Centered on the macula; camera: Topcon TRC-NW8; 50° FOV
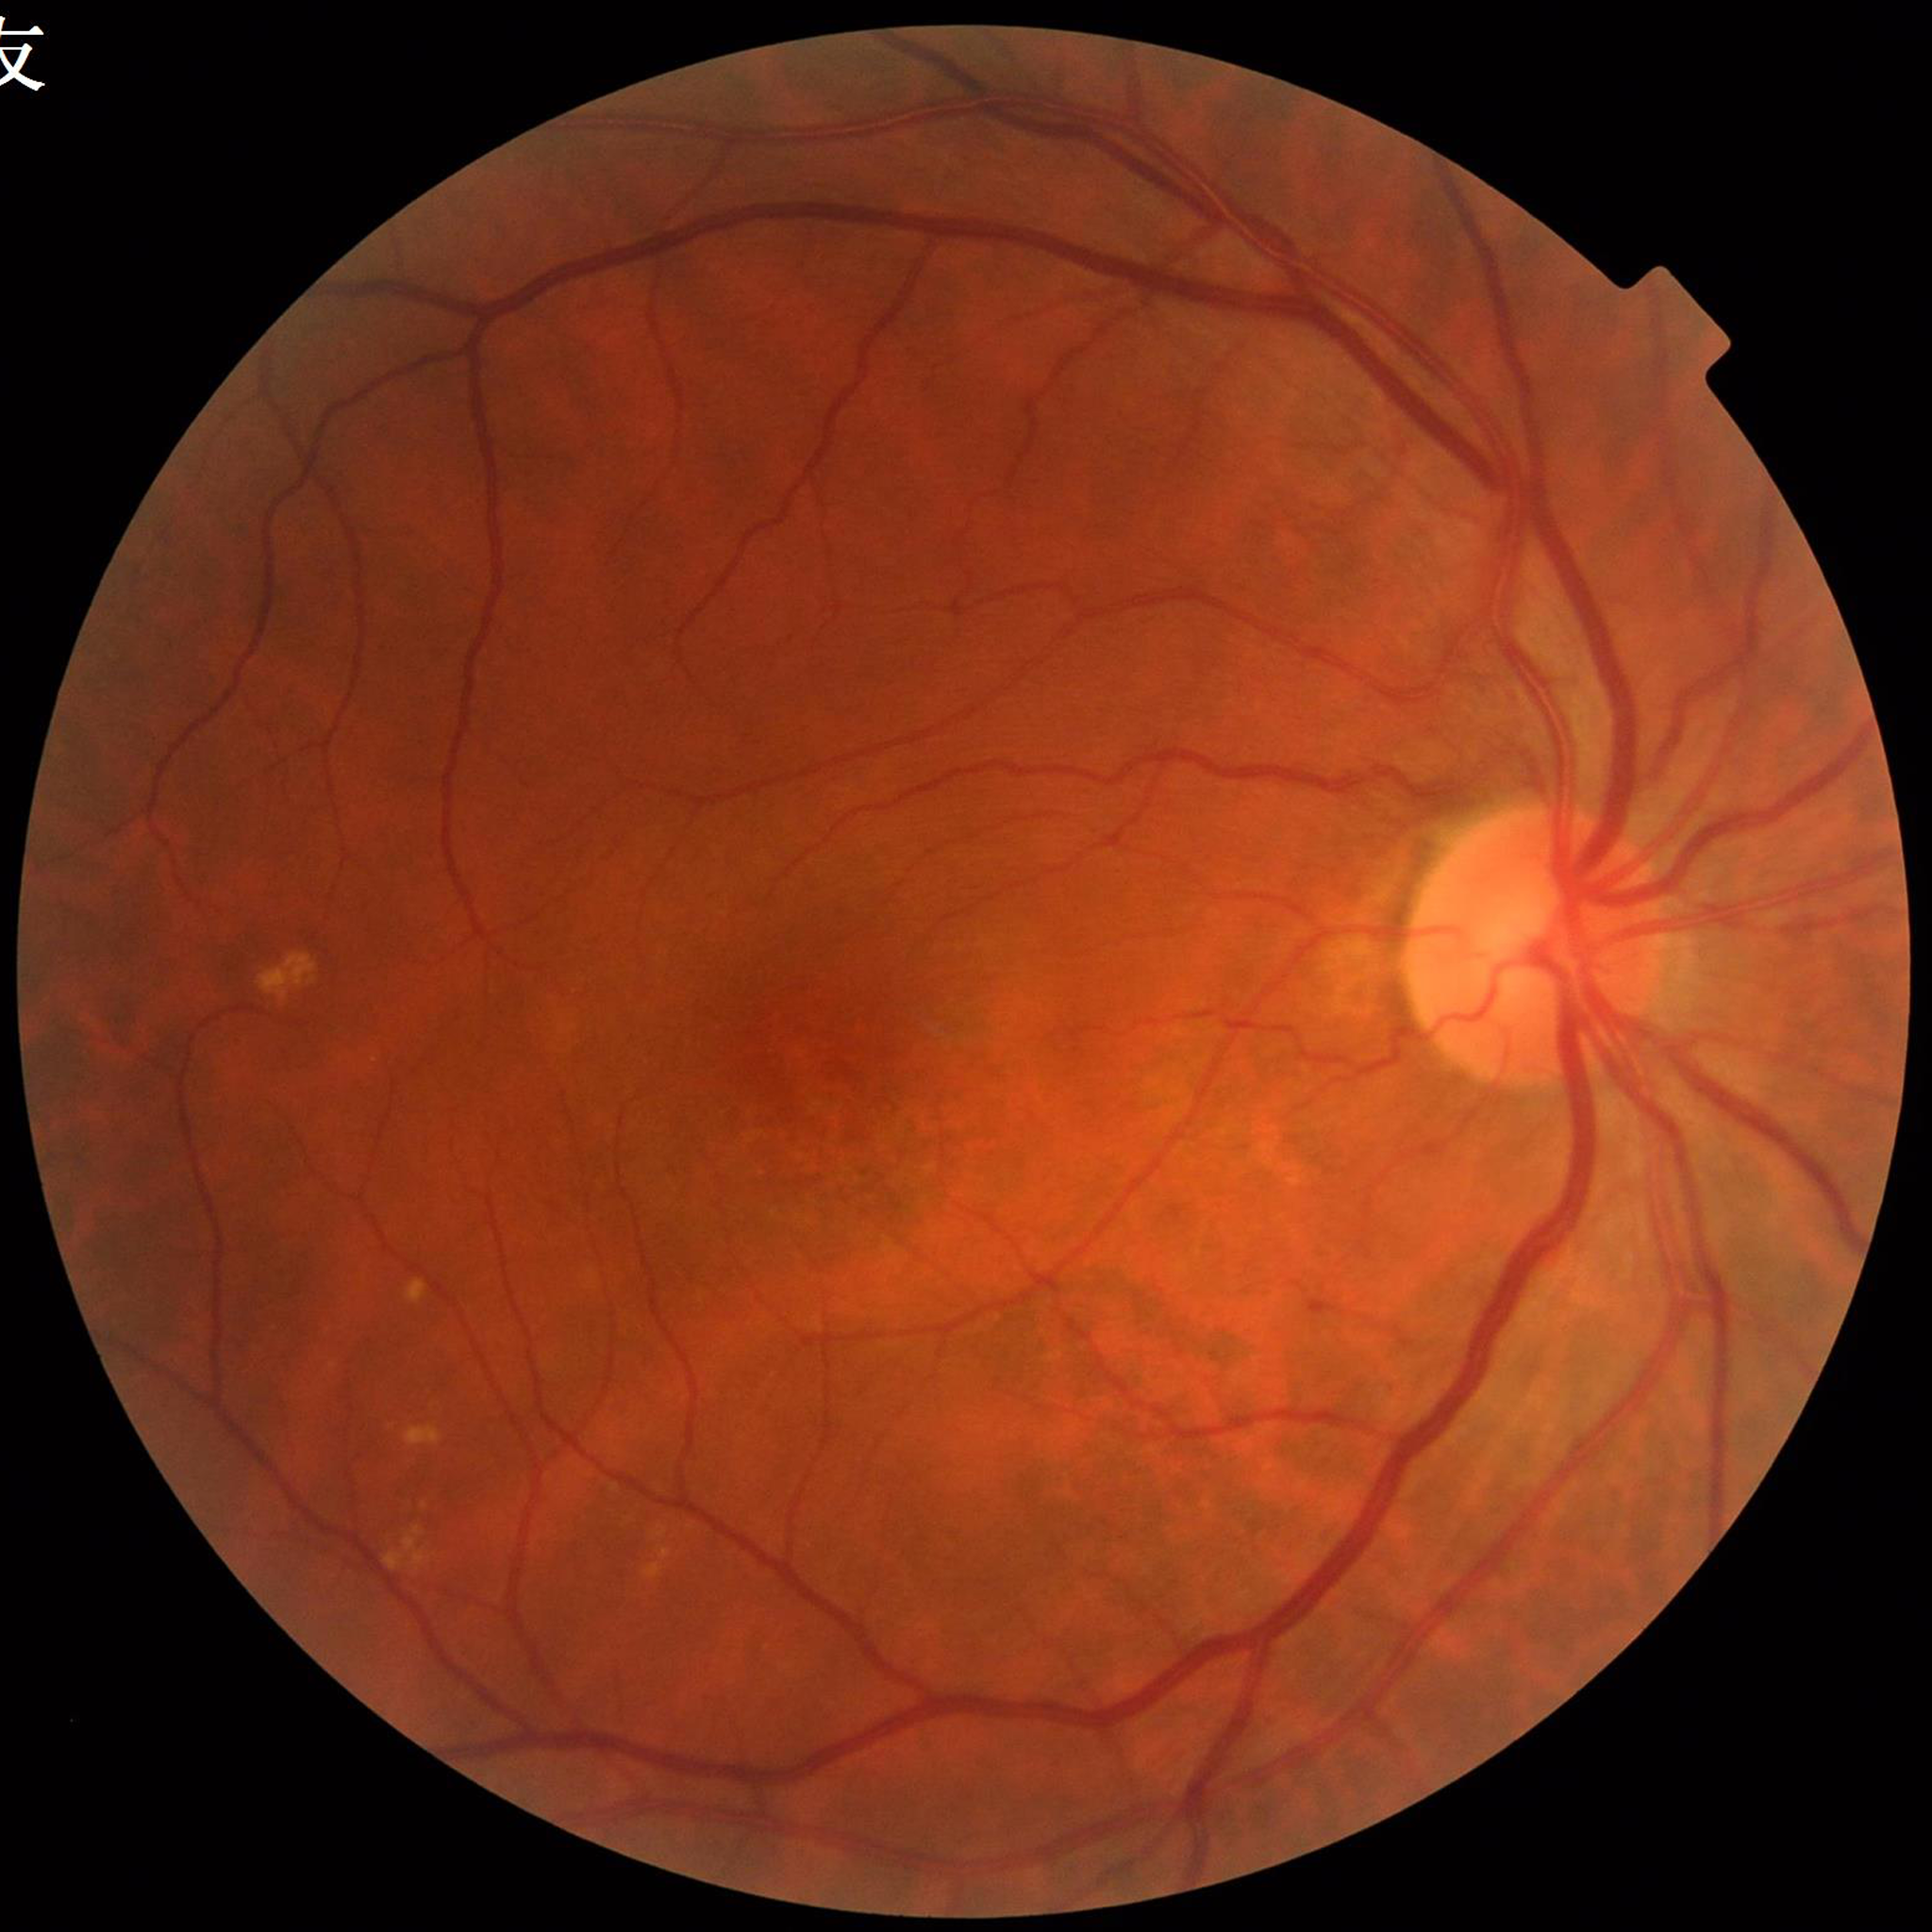
  image_quality: adequate
  diagnosis: age-related macular degeneration